DR severity per modified Davis staging:
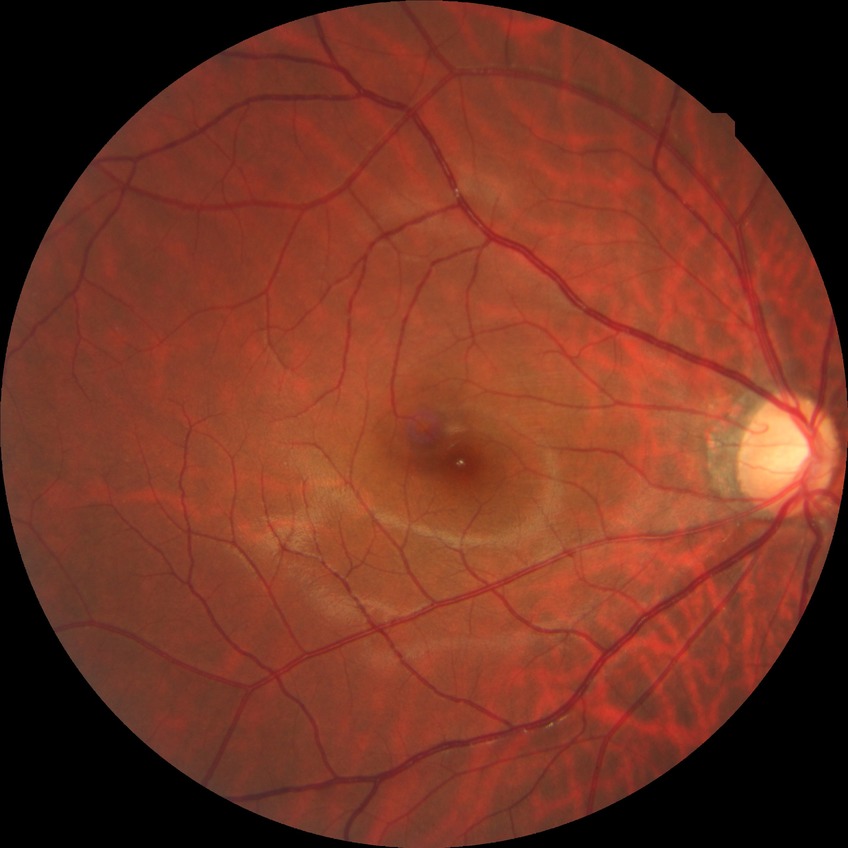
Diabetic retinopathy (DR) is NDR (no diabetic retinopathy).